2352 by 1568 pixels · fundus photo: 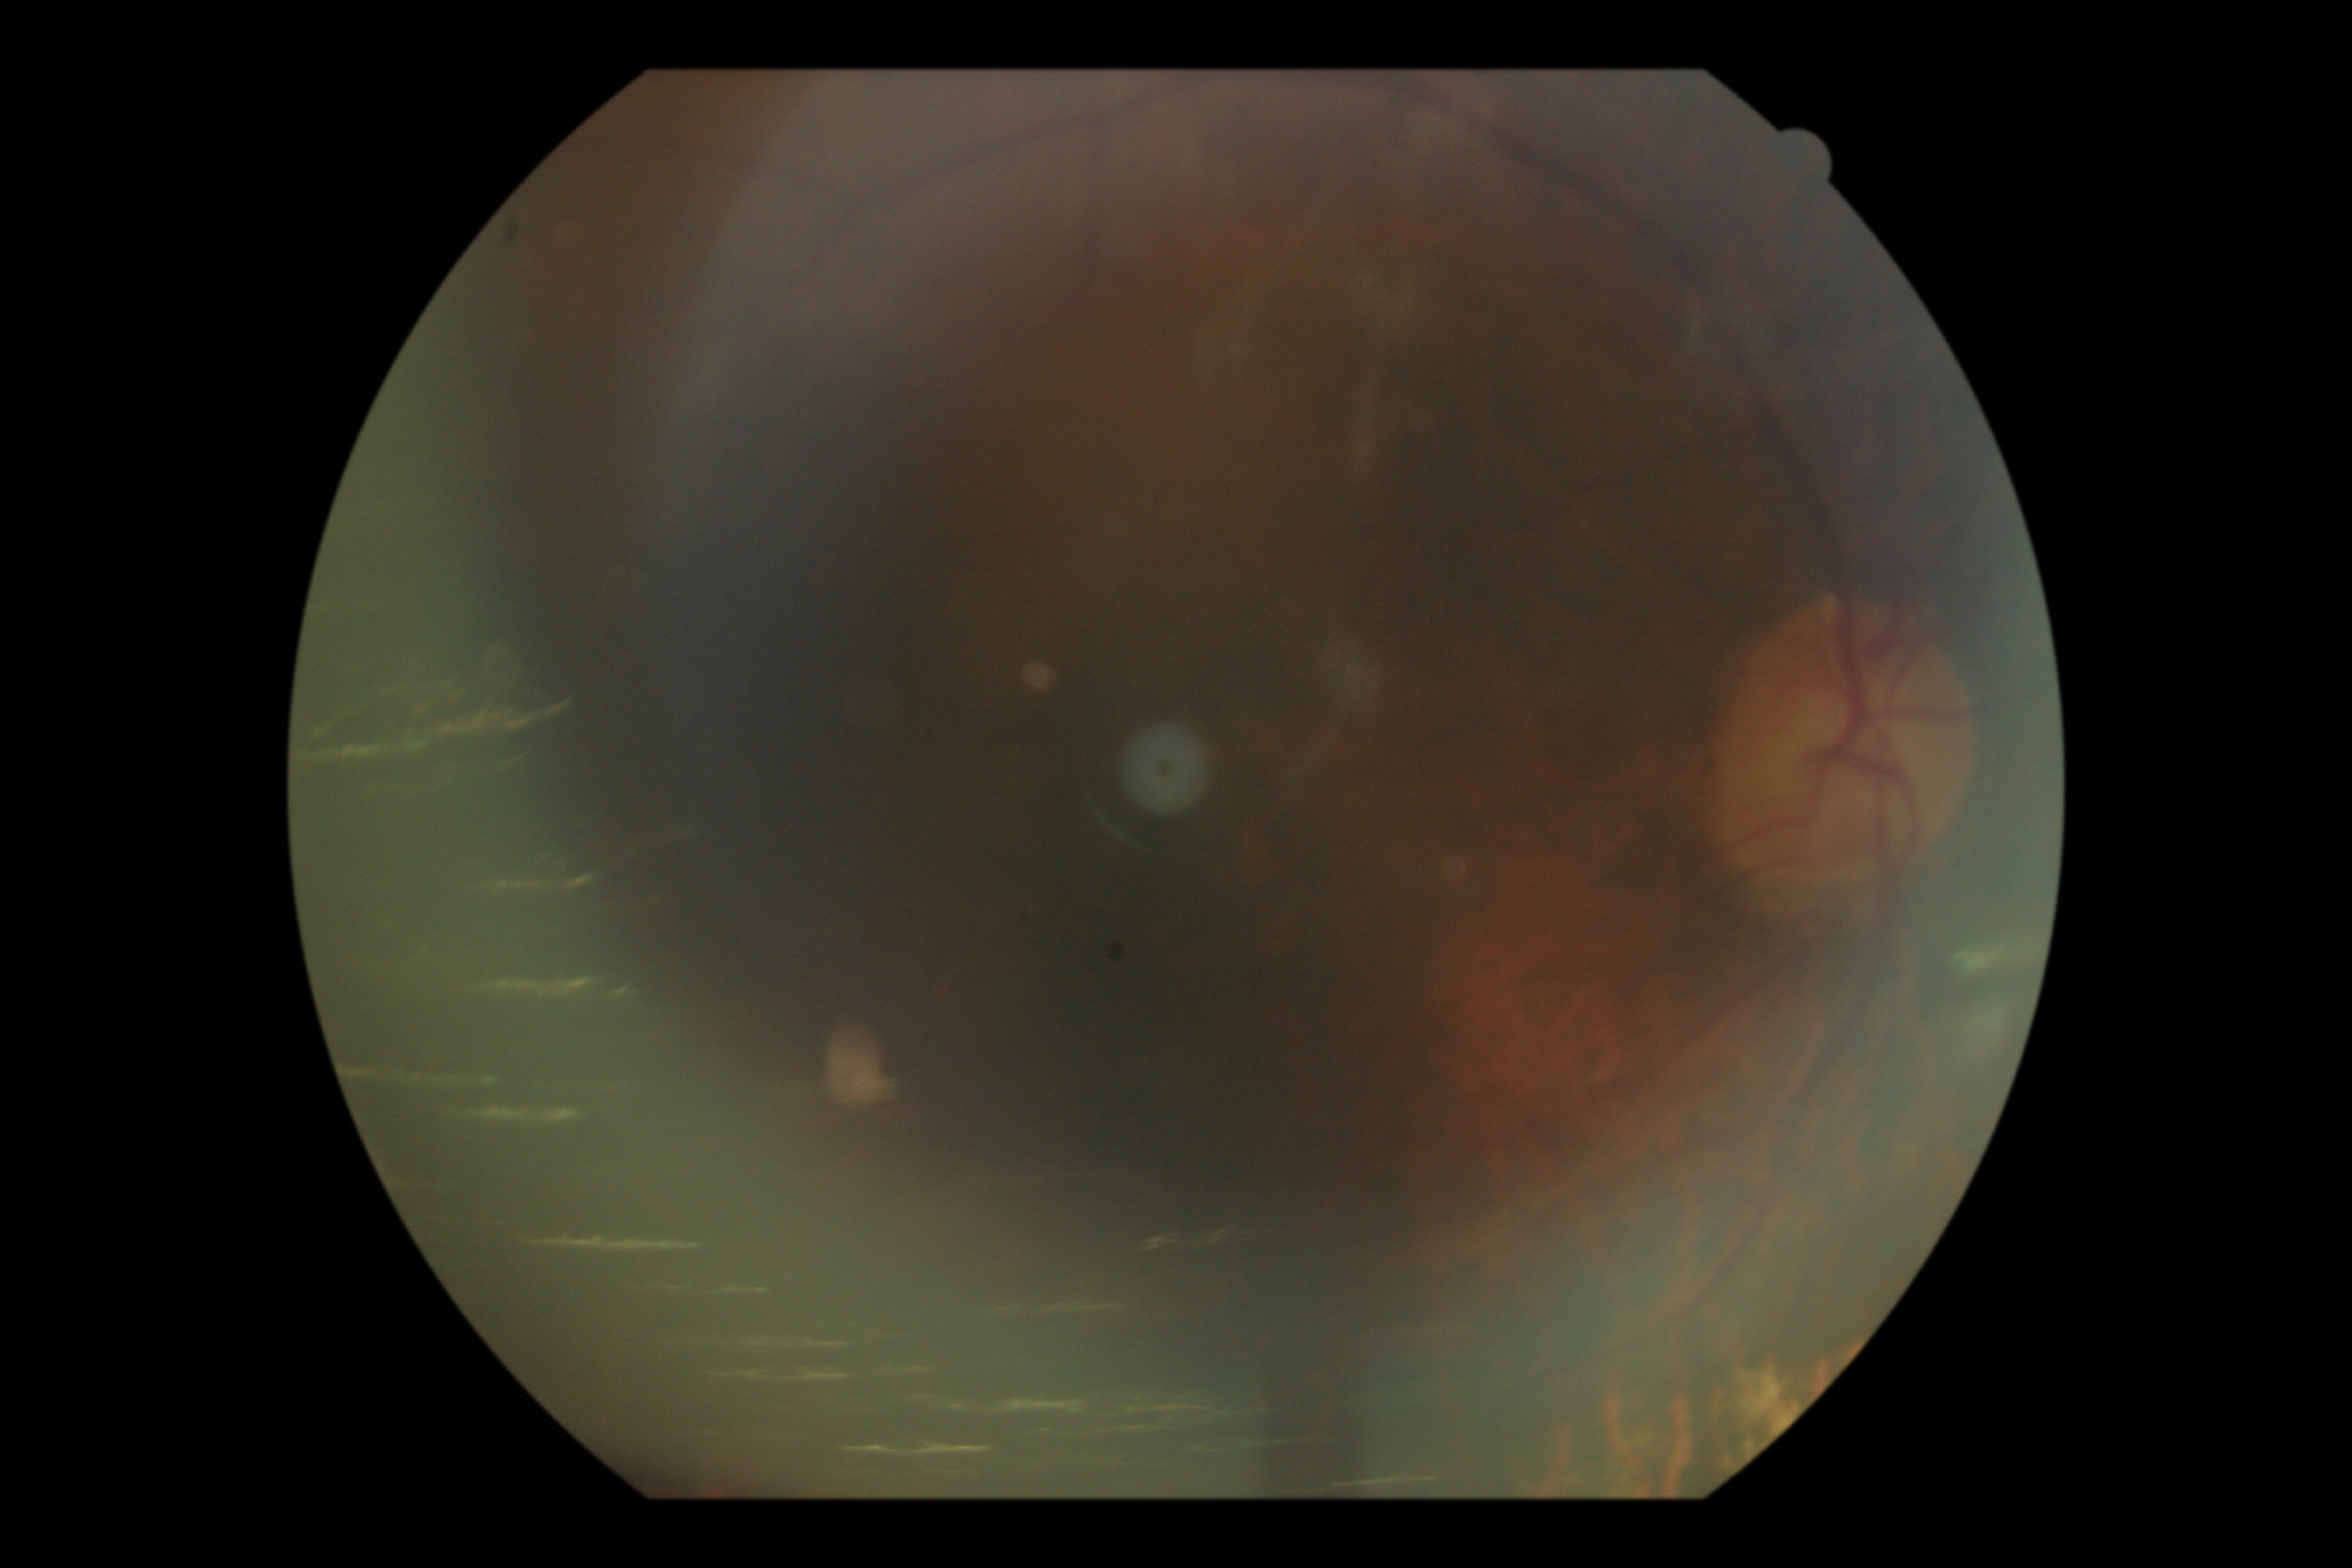 DR severity: ungradable due to poor image quality.